45° FOV: 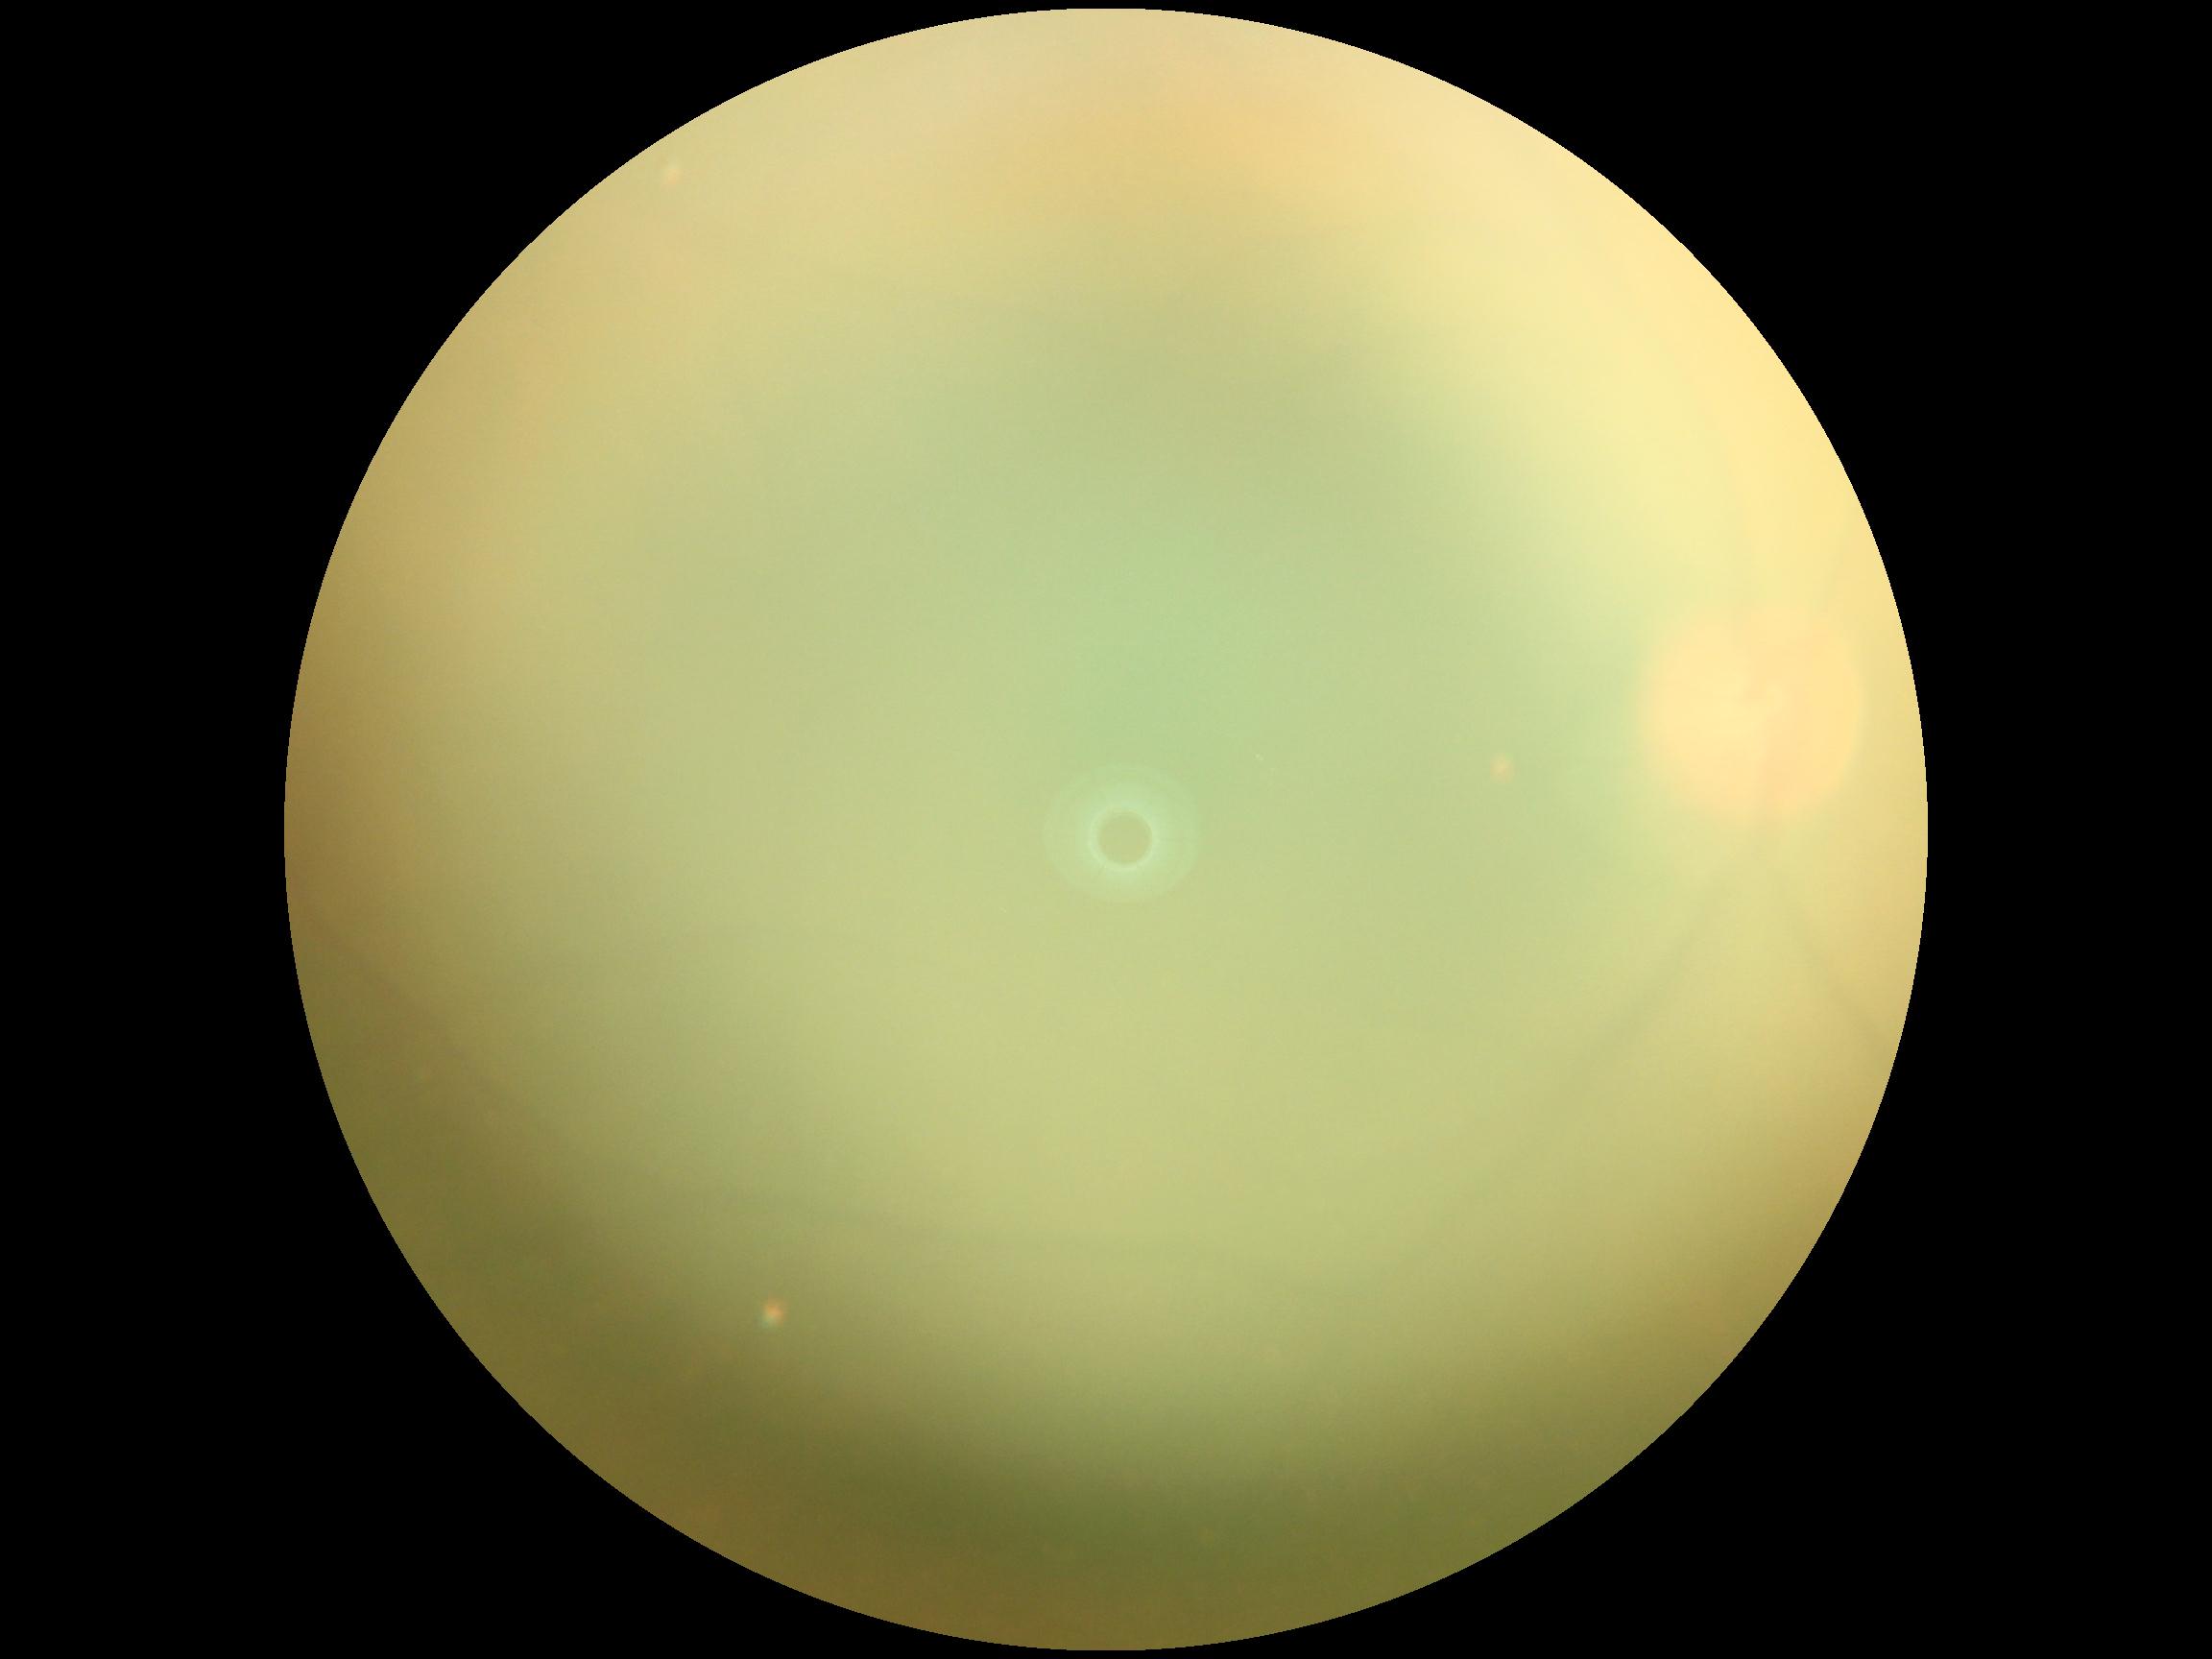
{"dr_grade": "ungradable"}